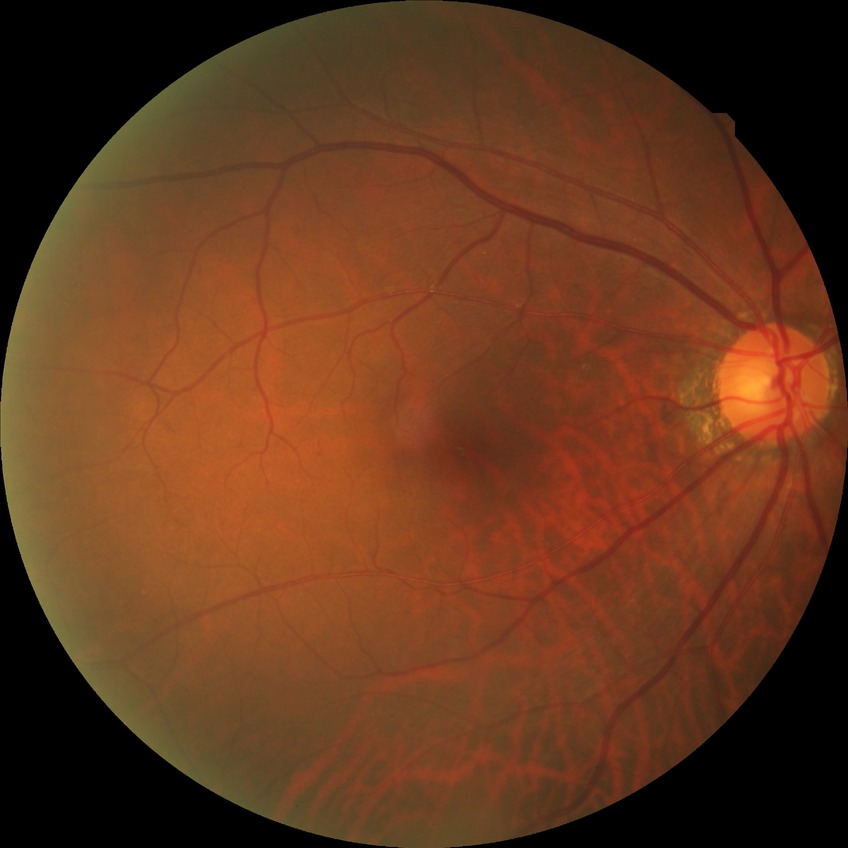
Davis grading is no diabetic retinopathy.